45° FOV — 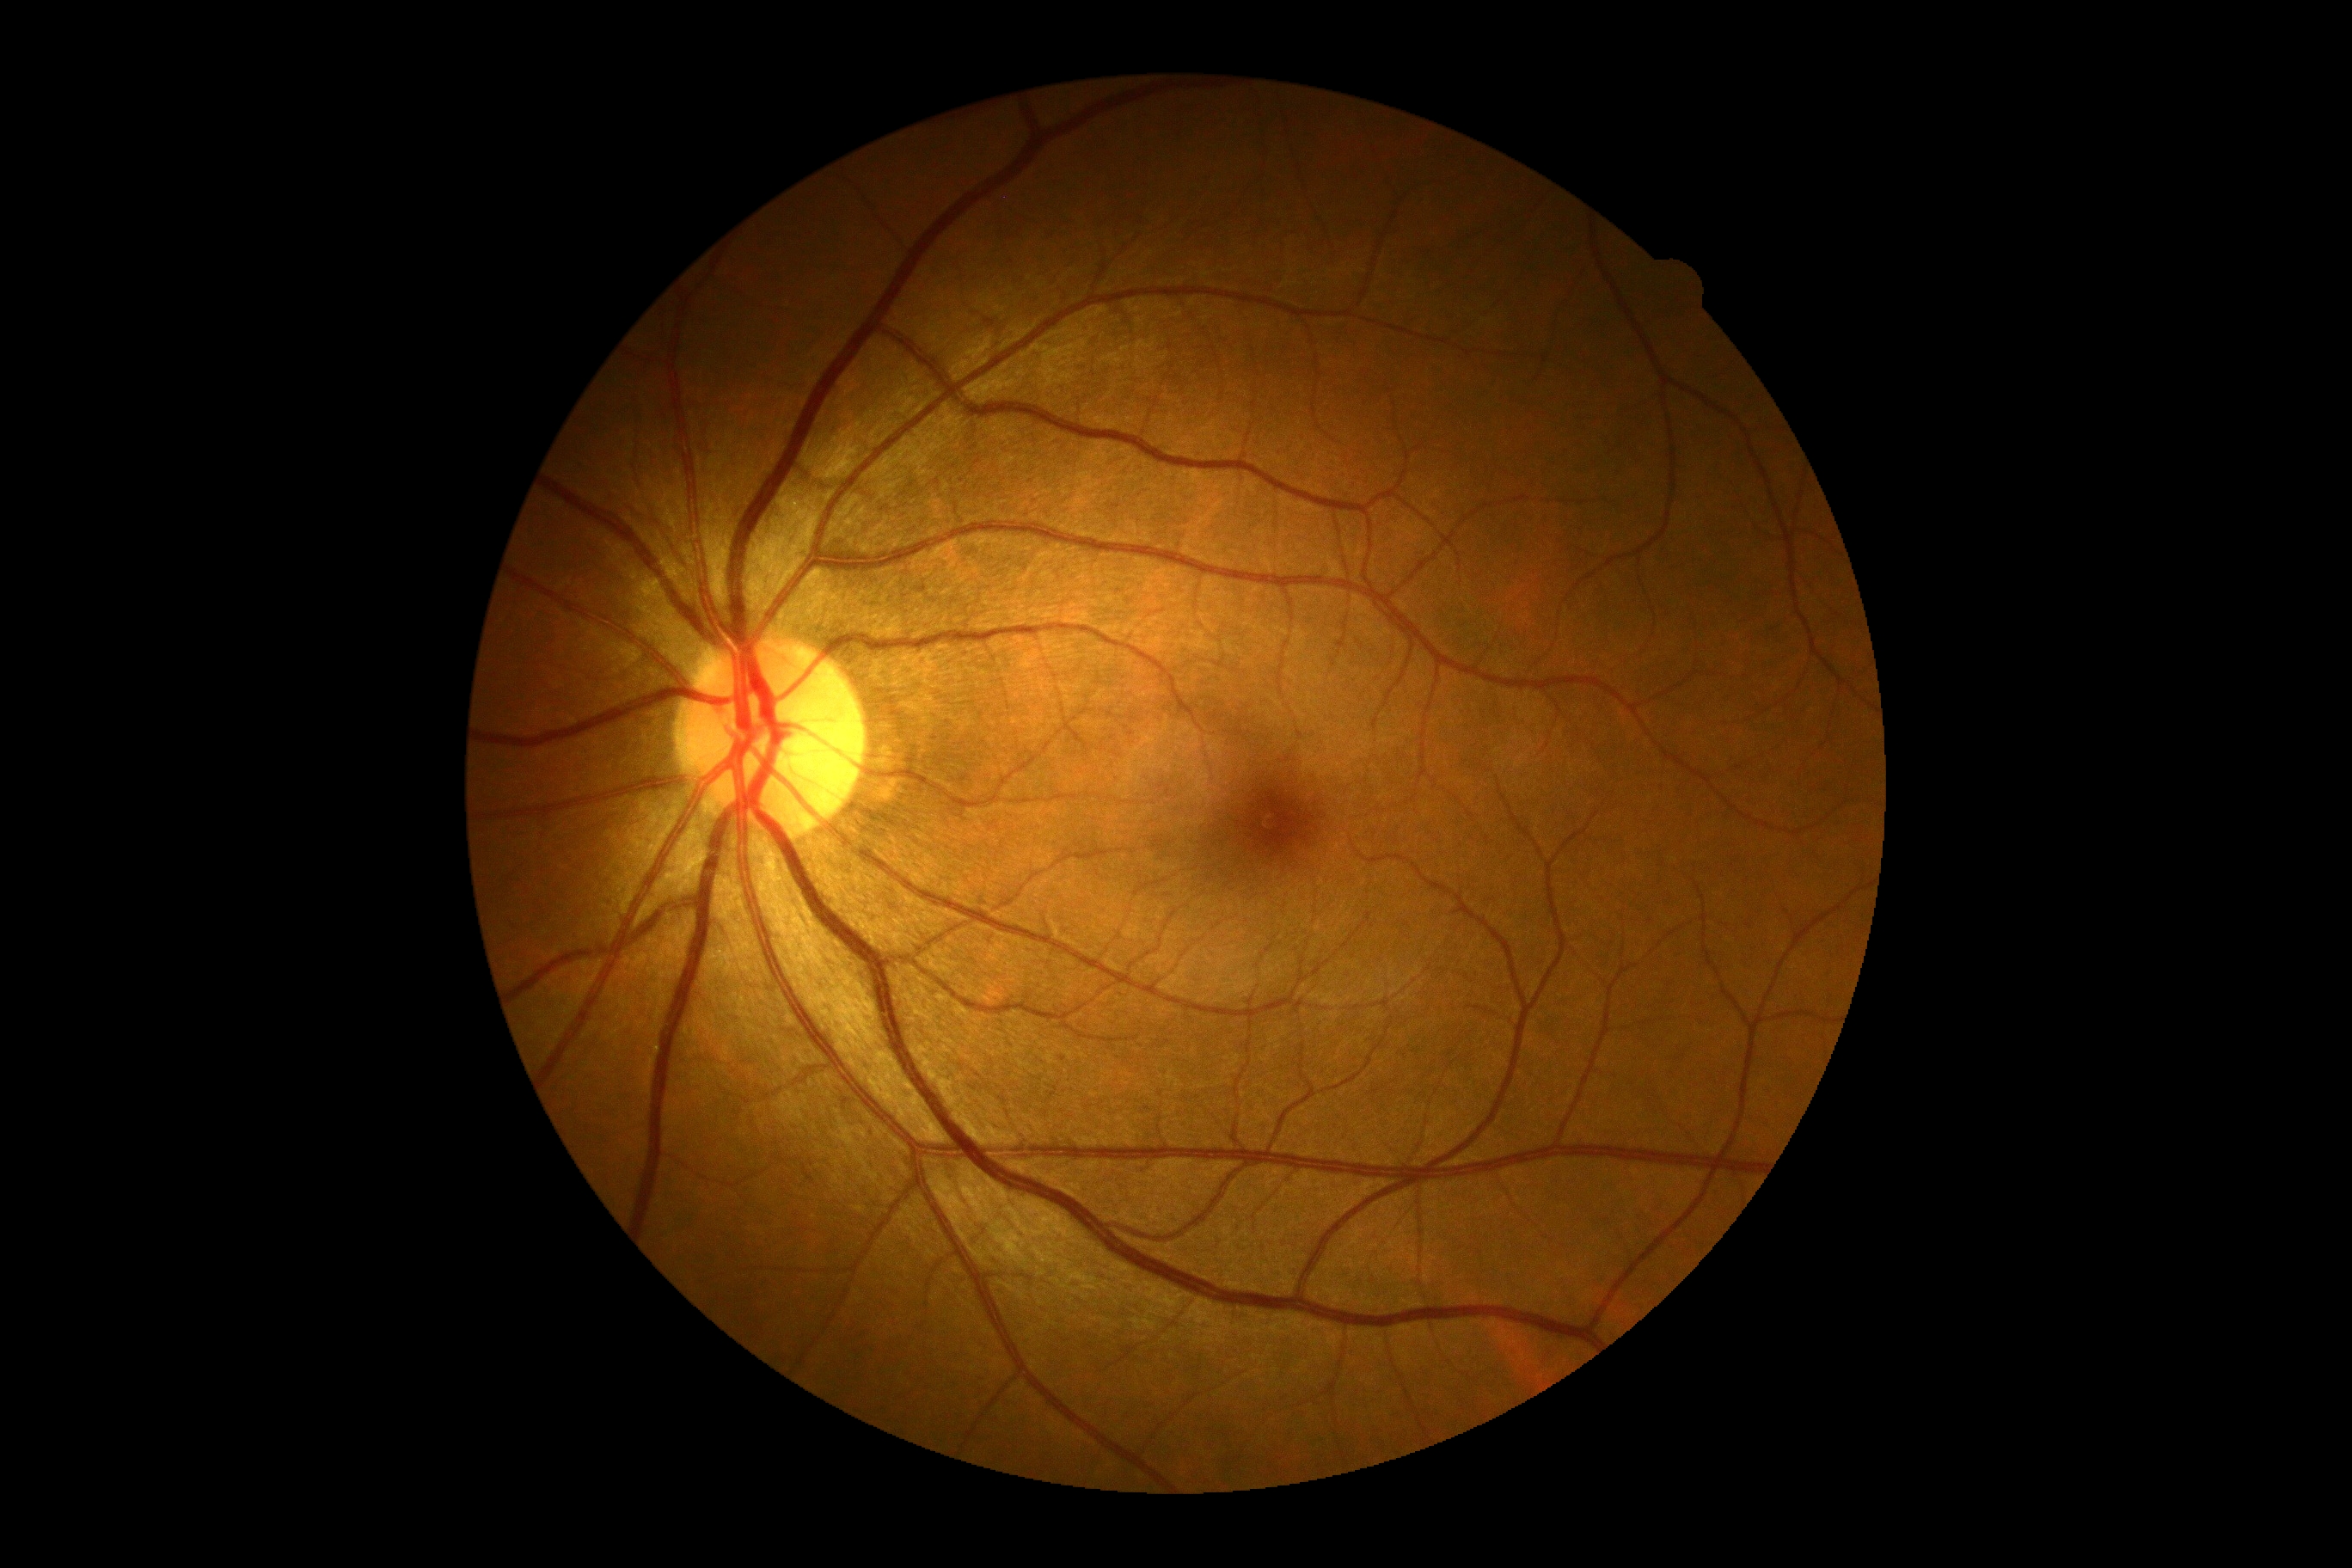

diabetic retinopathy (DR): 0 — no visible signs of diabetic retinopathy.